640 x 480 pixels · infant wide-field fundus photograph · acquired on the Clarity RetCam 3.
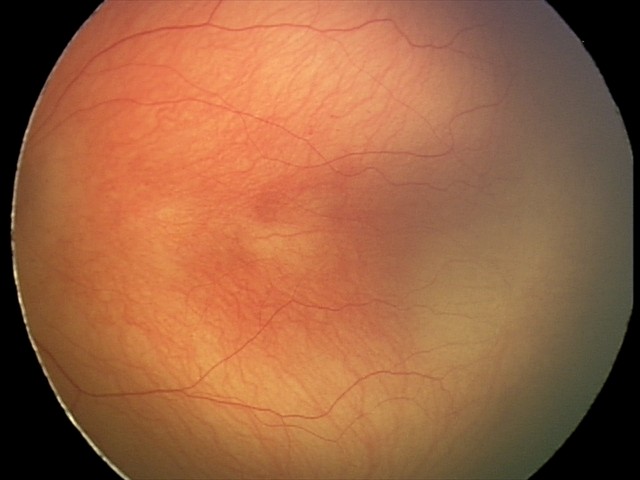 Examination diagnosed as retinopathy of prematurity stage 2.